Fundus photo: 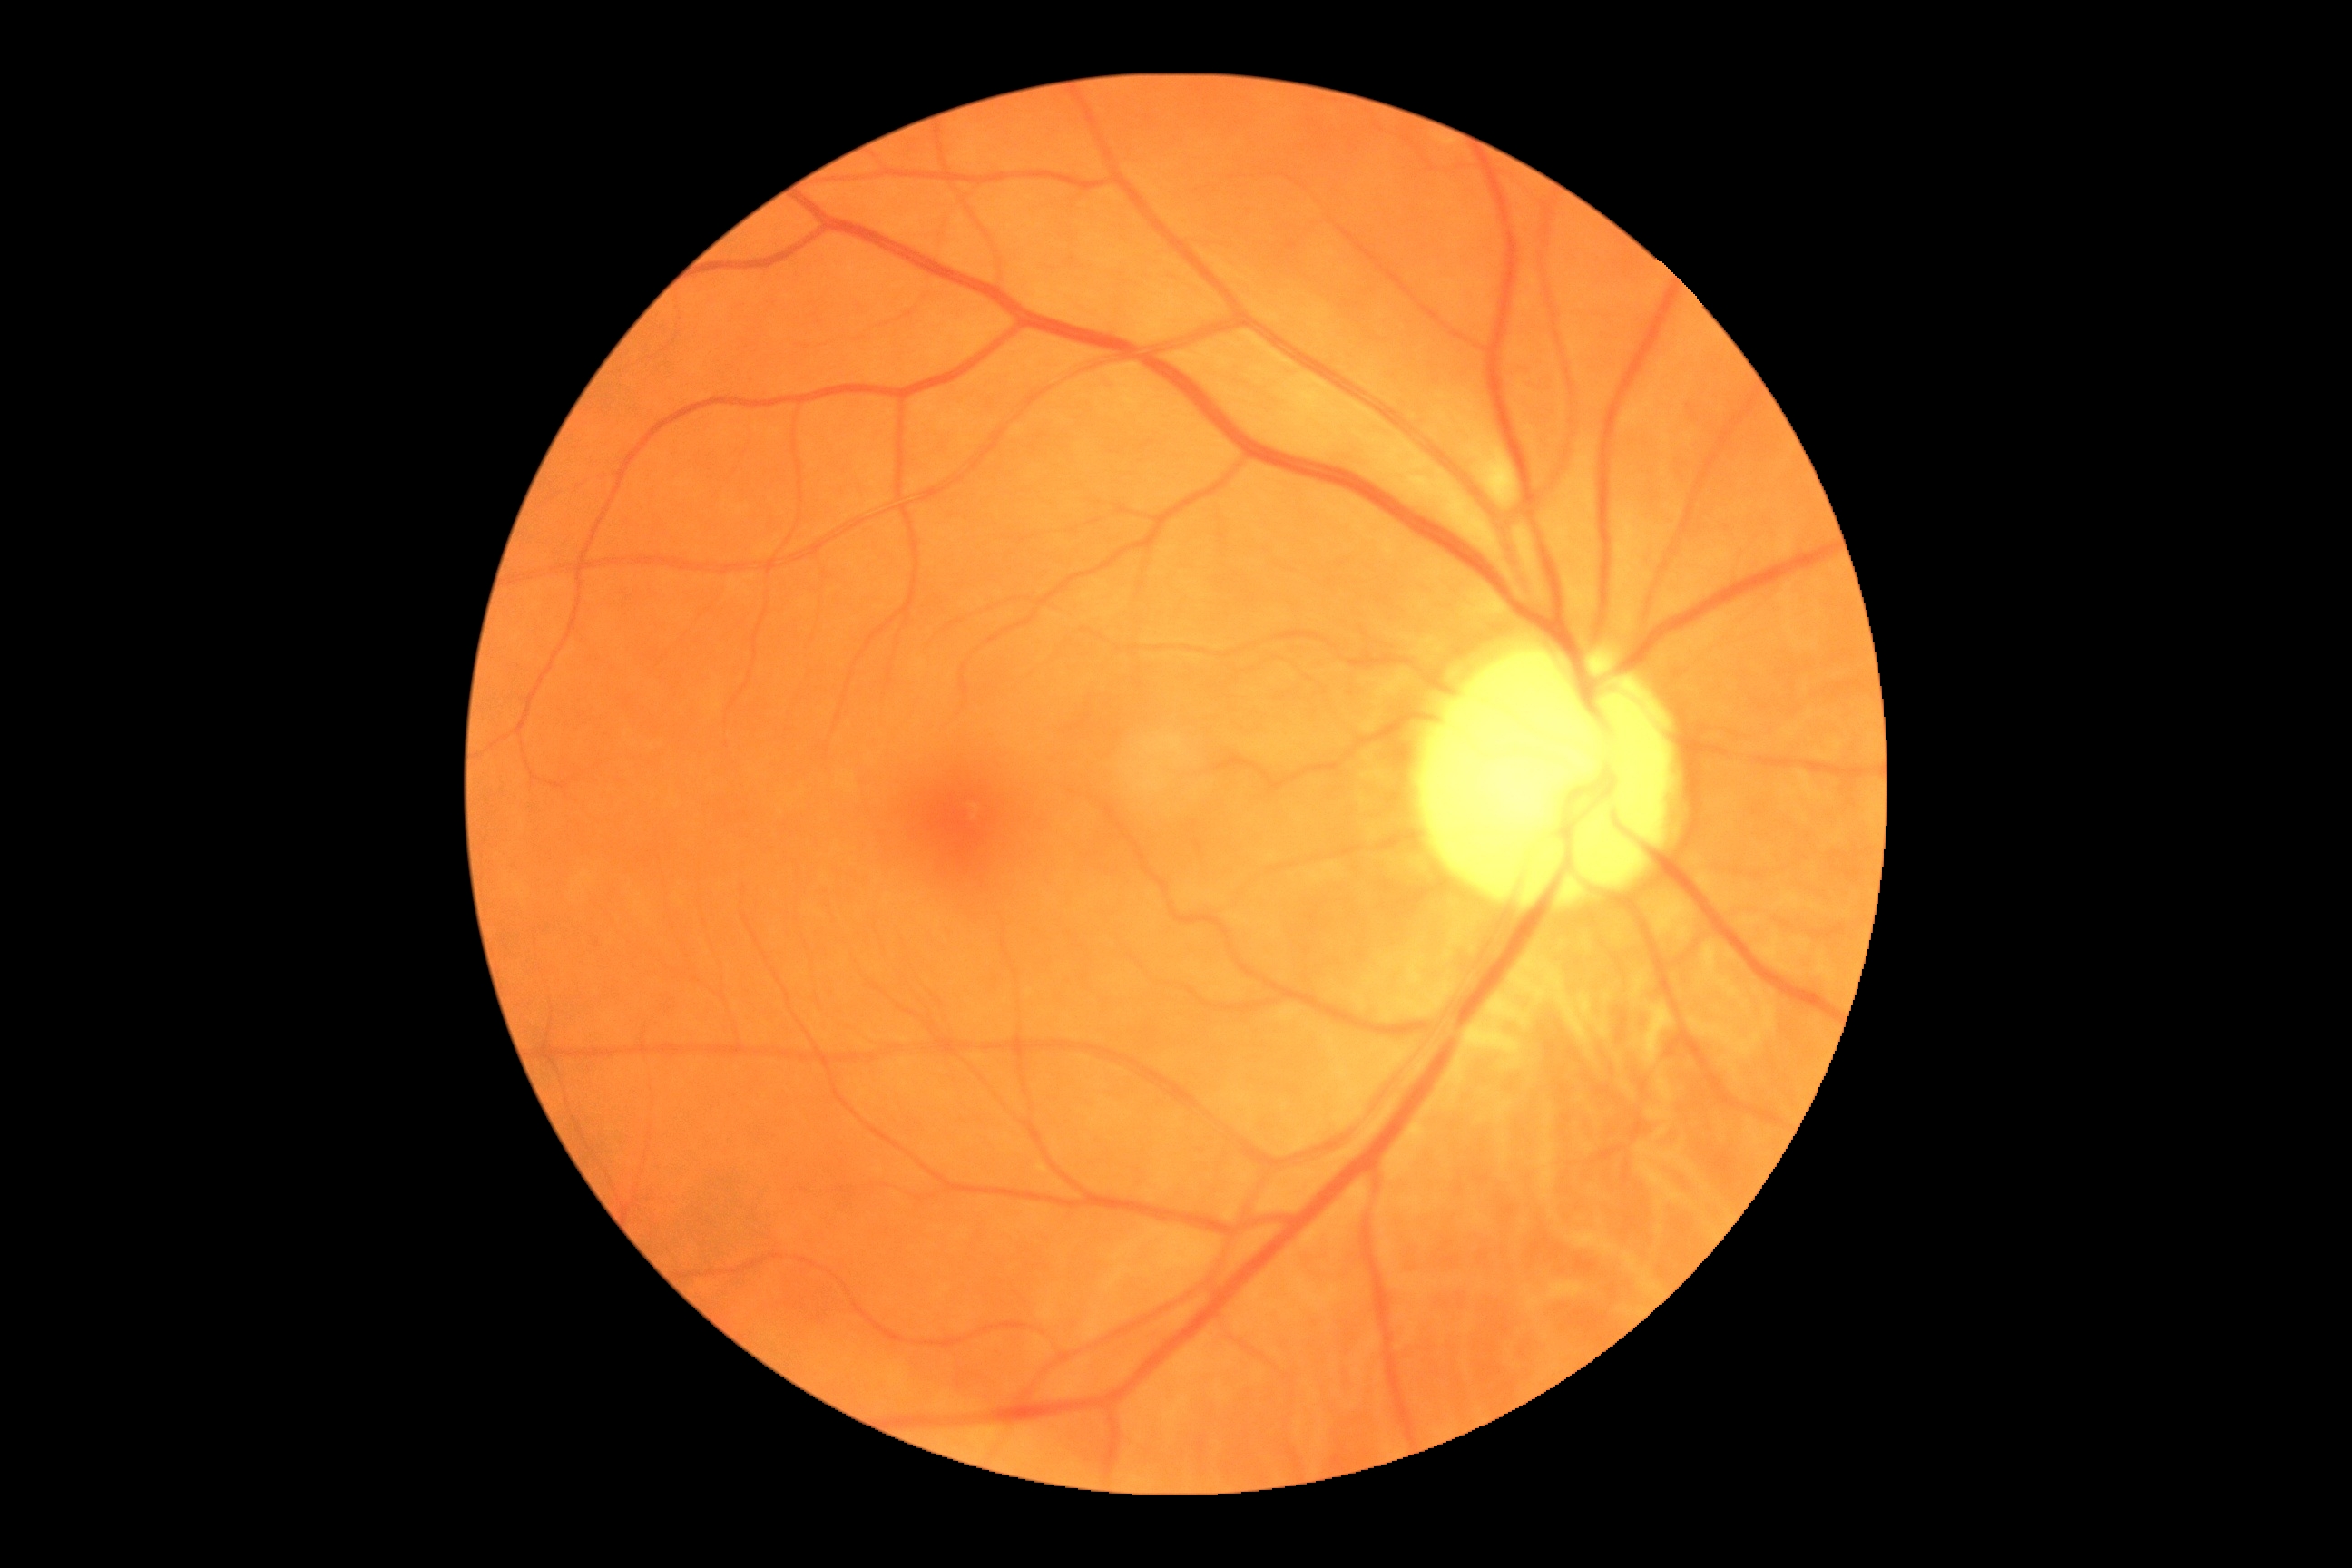 {"dr_category": "non-proliferative diabetic retinopathy", "dr_grade": "moderate non-proliferative diabetic retinopathy (2)"}